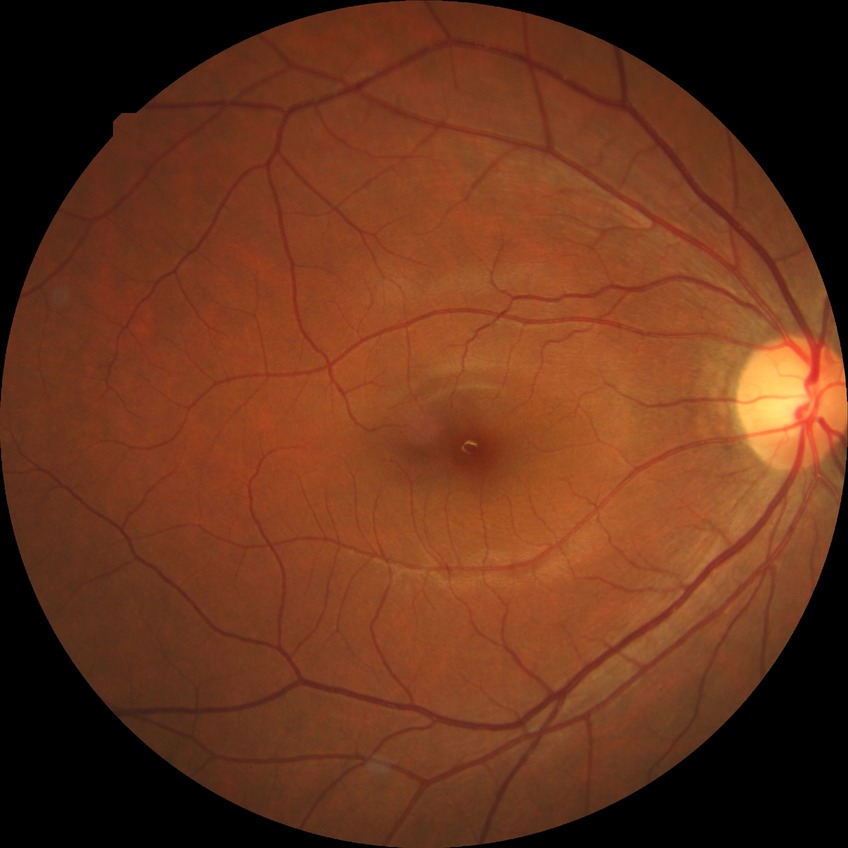 Diabetic retinopathy (DR): no diabetic retinopathy (NDR).